Nonmydriatic · 848x848px · modified Davis grading: 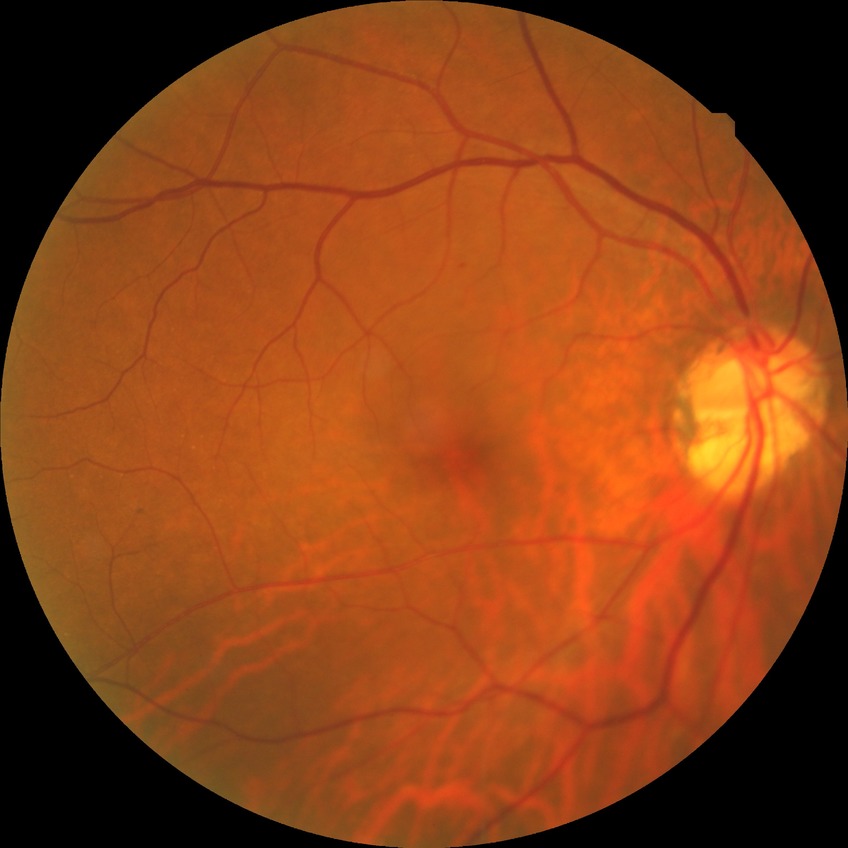
Davis grading: no diabetic retinopathy.